Retinal fundus photograph — 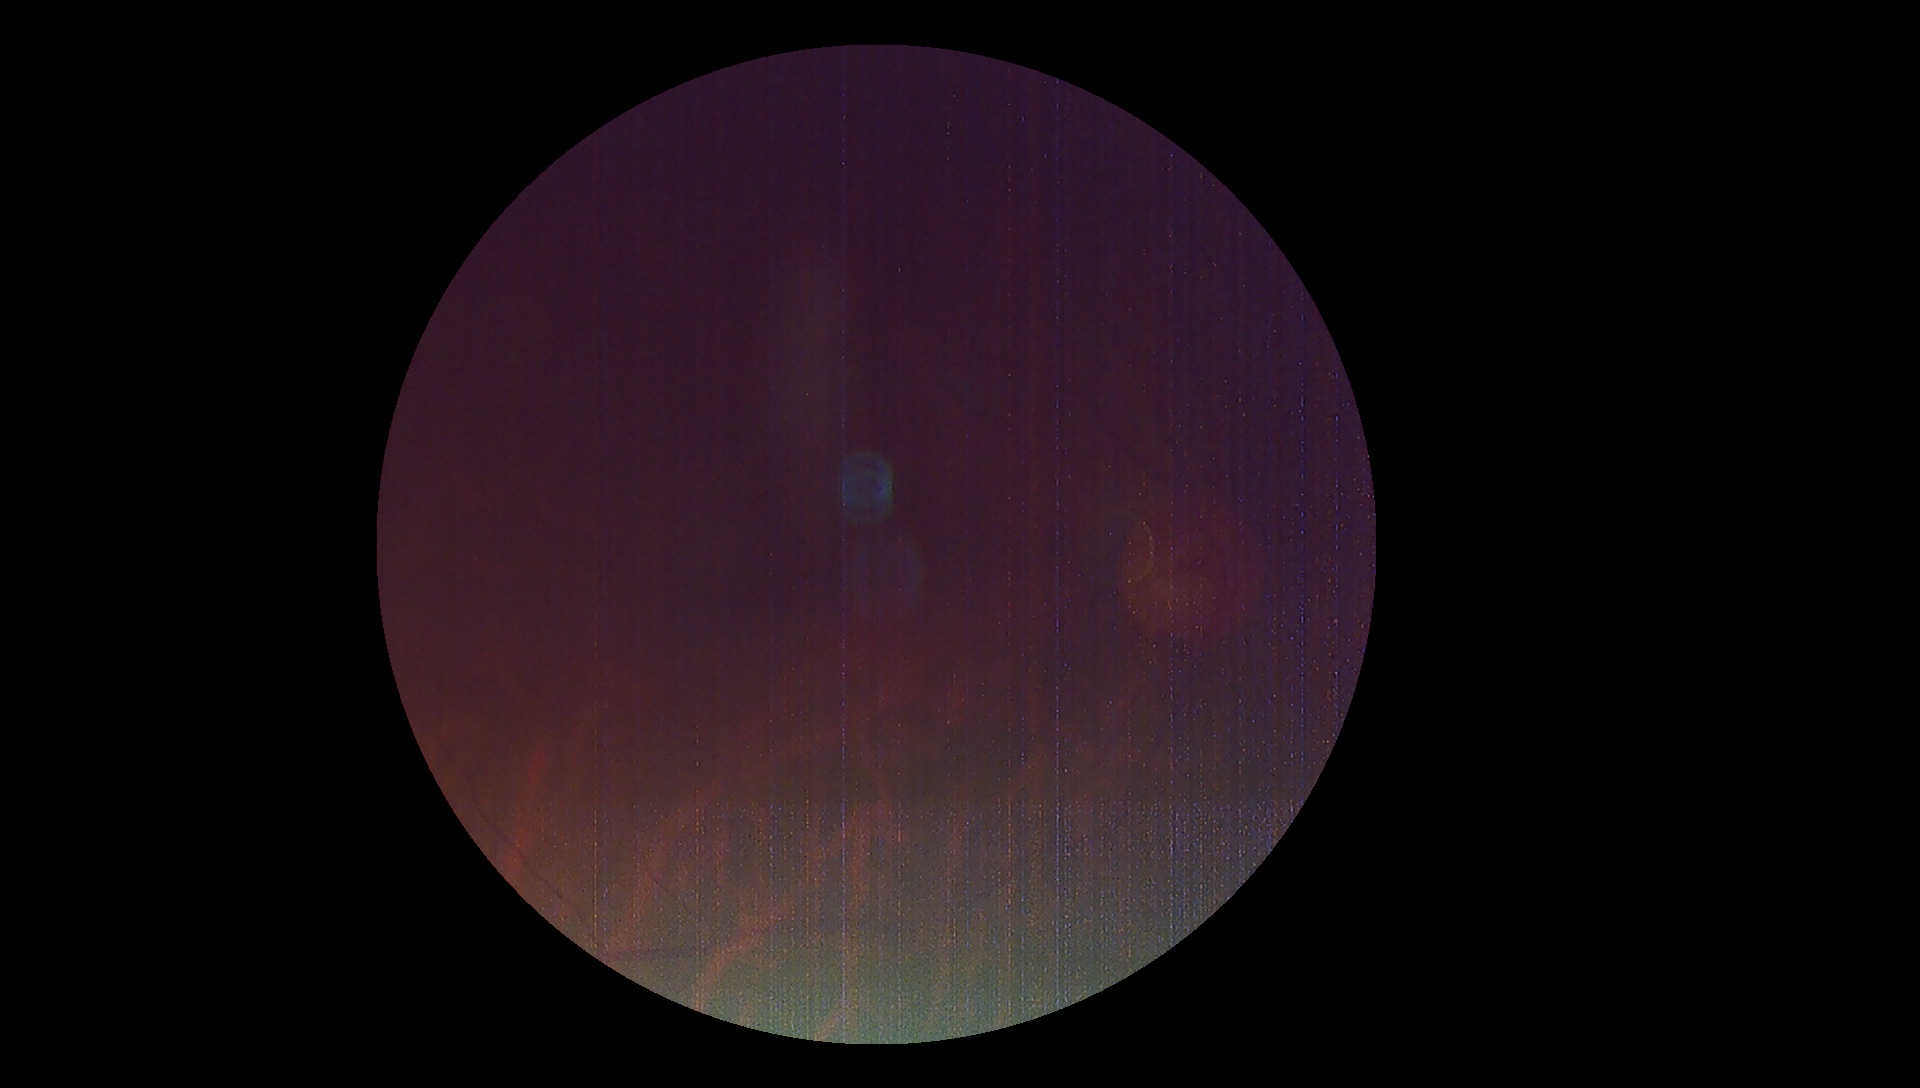
Diabetic retinopathy (DR) is ungradable. Ungradable image — DR severity cannot be determined.